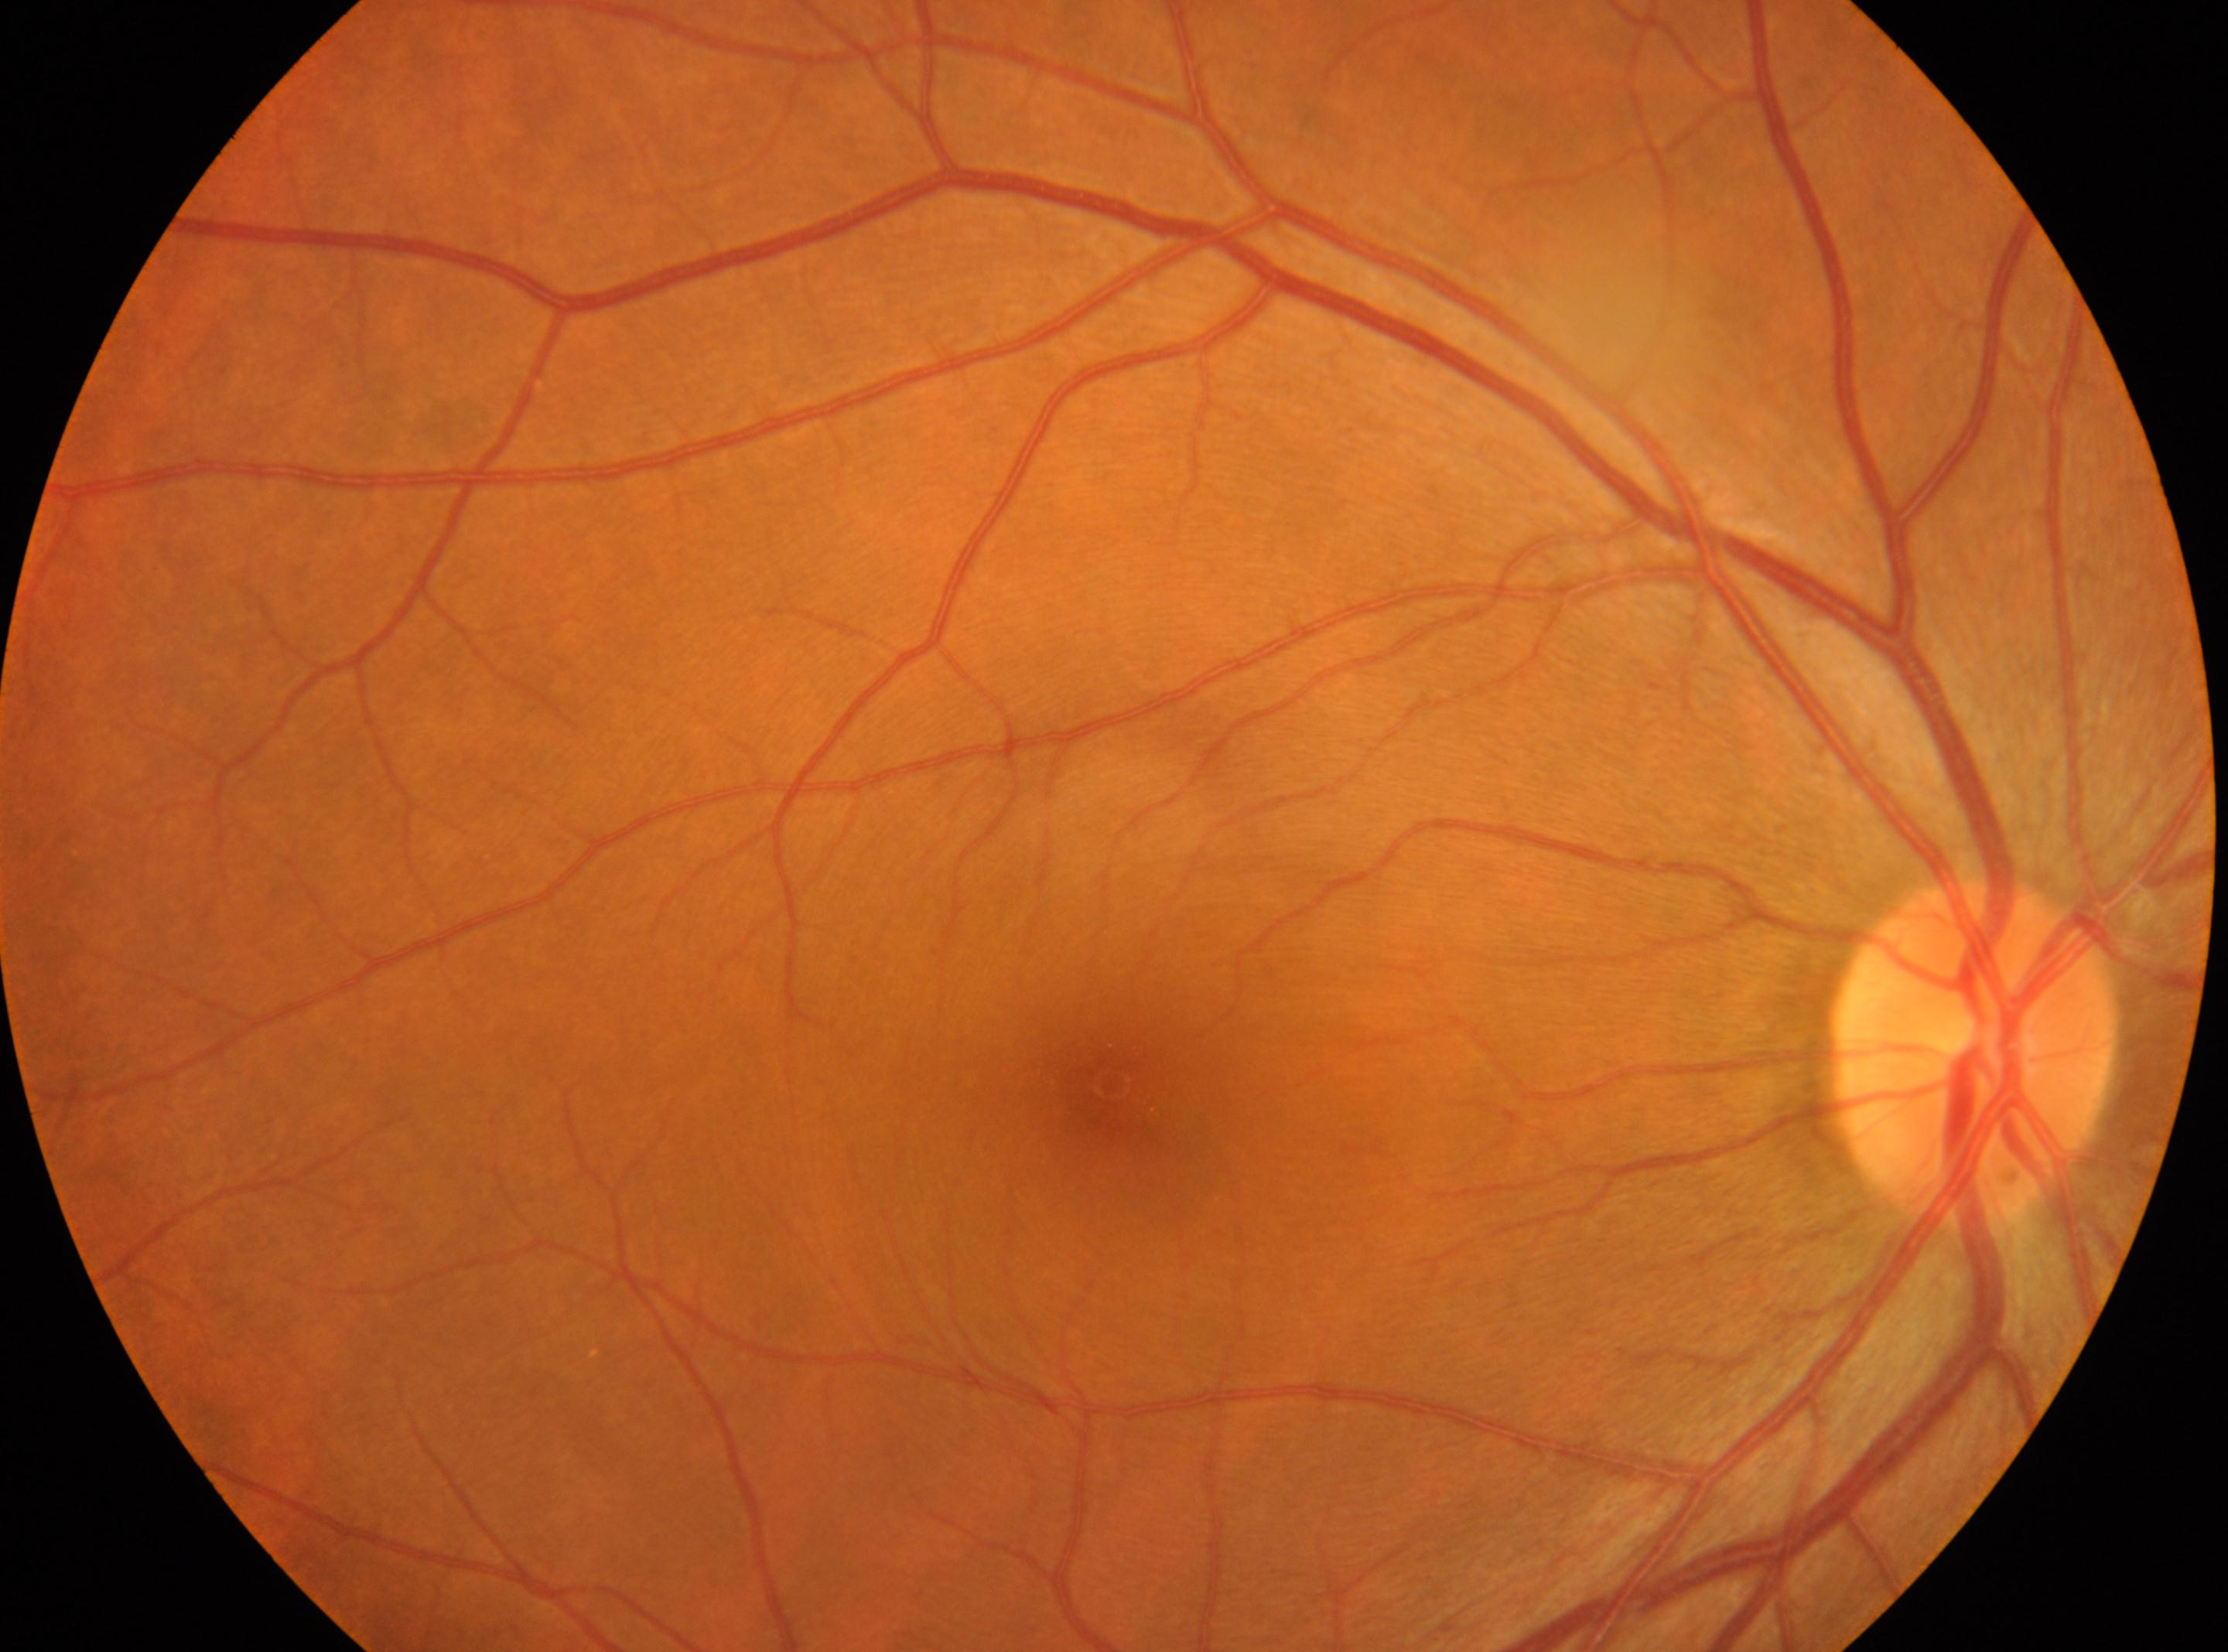
Optic nerve head: 1974, 1053. DR: grade 0. No signs of diabetic retinopathy. Fovea: 1111, 1084. This is the right eye.